Wide-field fundus photograph of an infant — 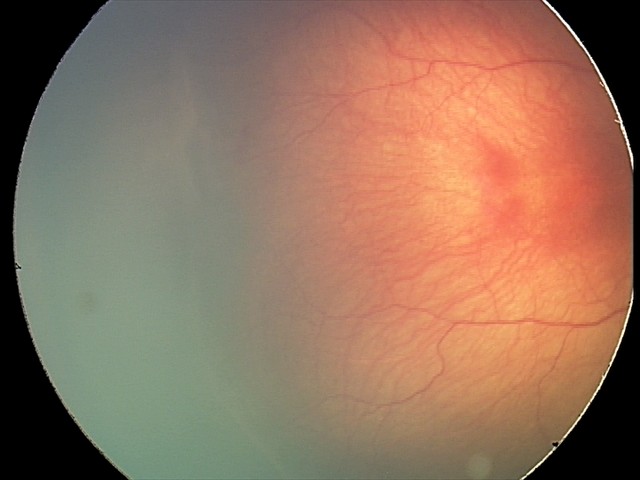
Plus disease: absent | ROP: stage 2.